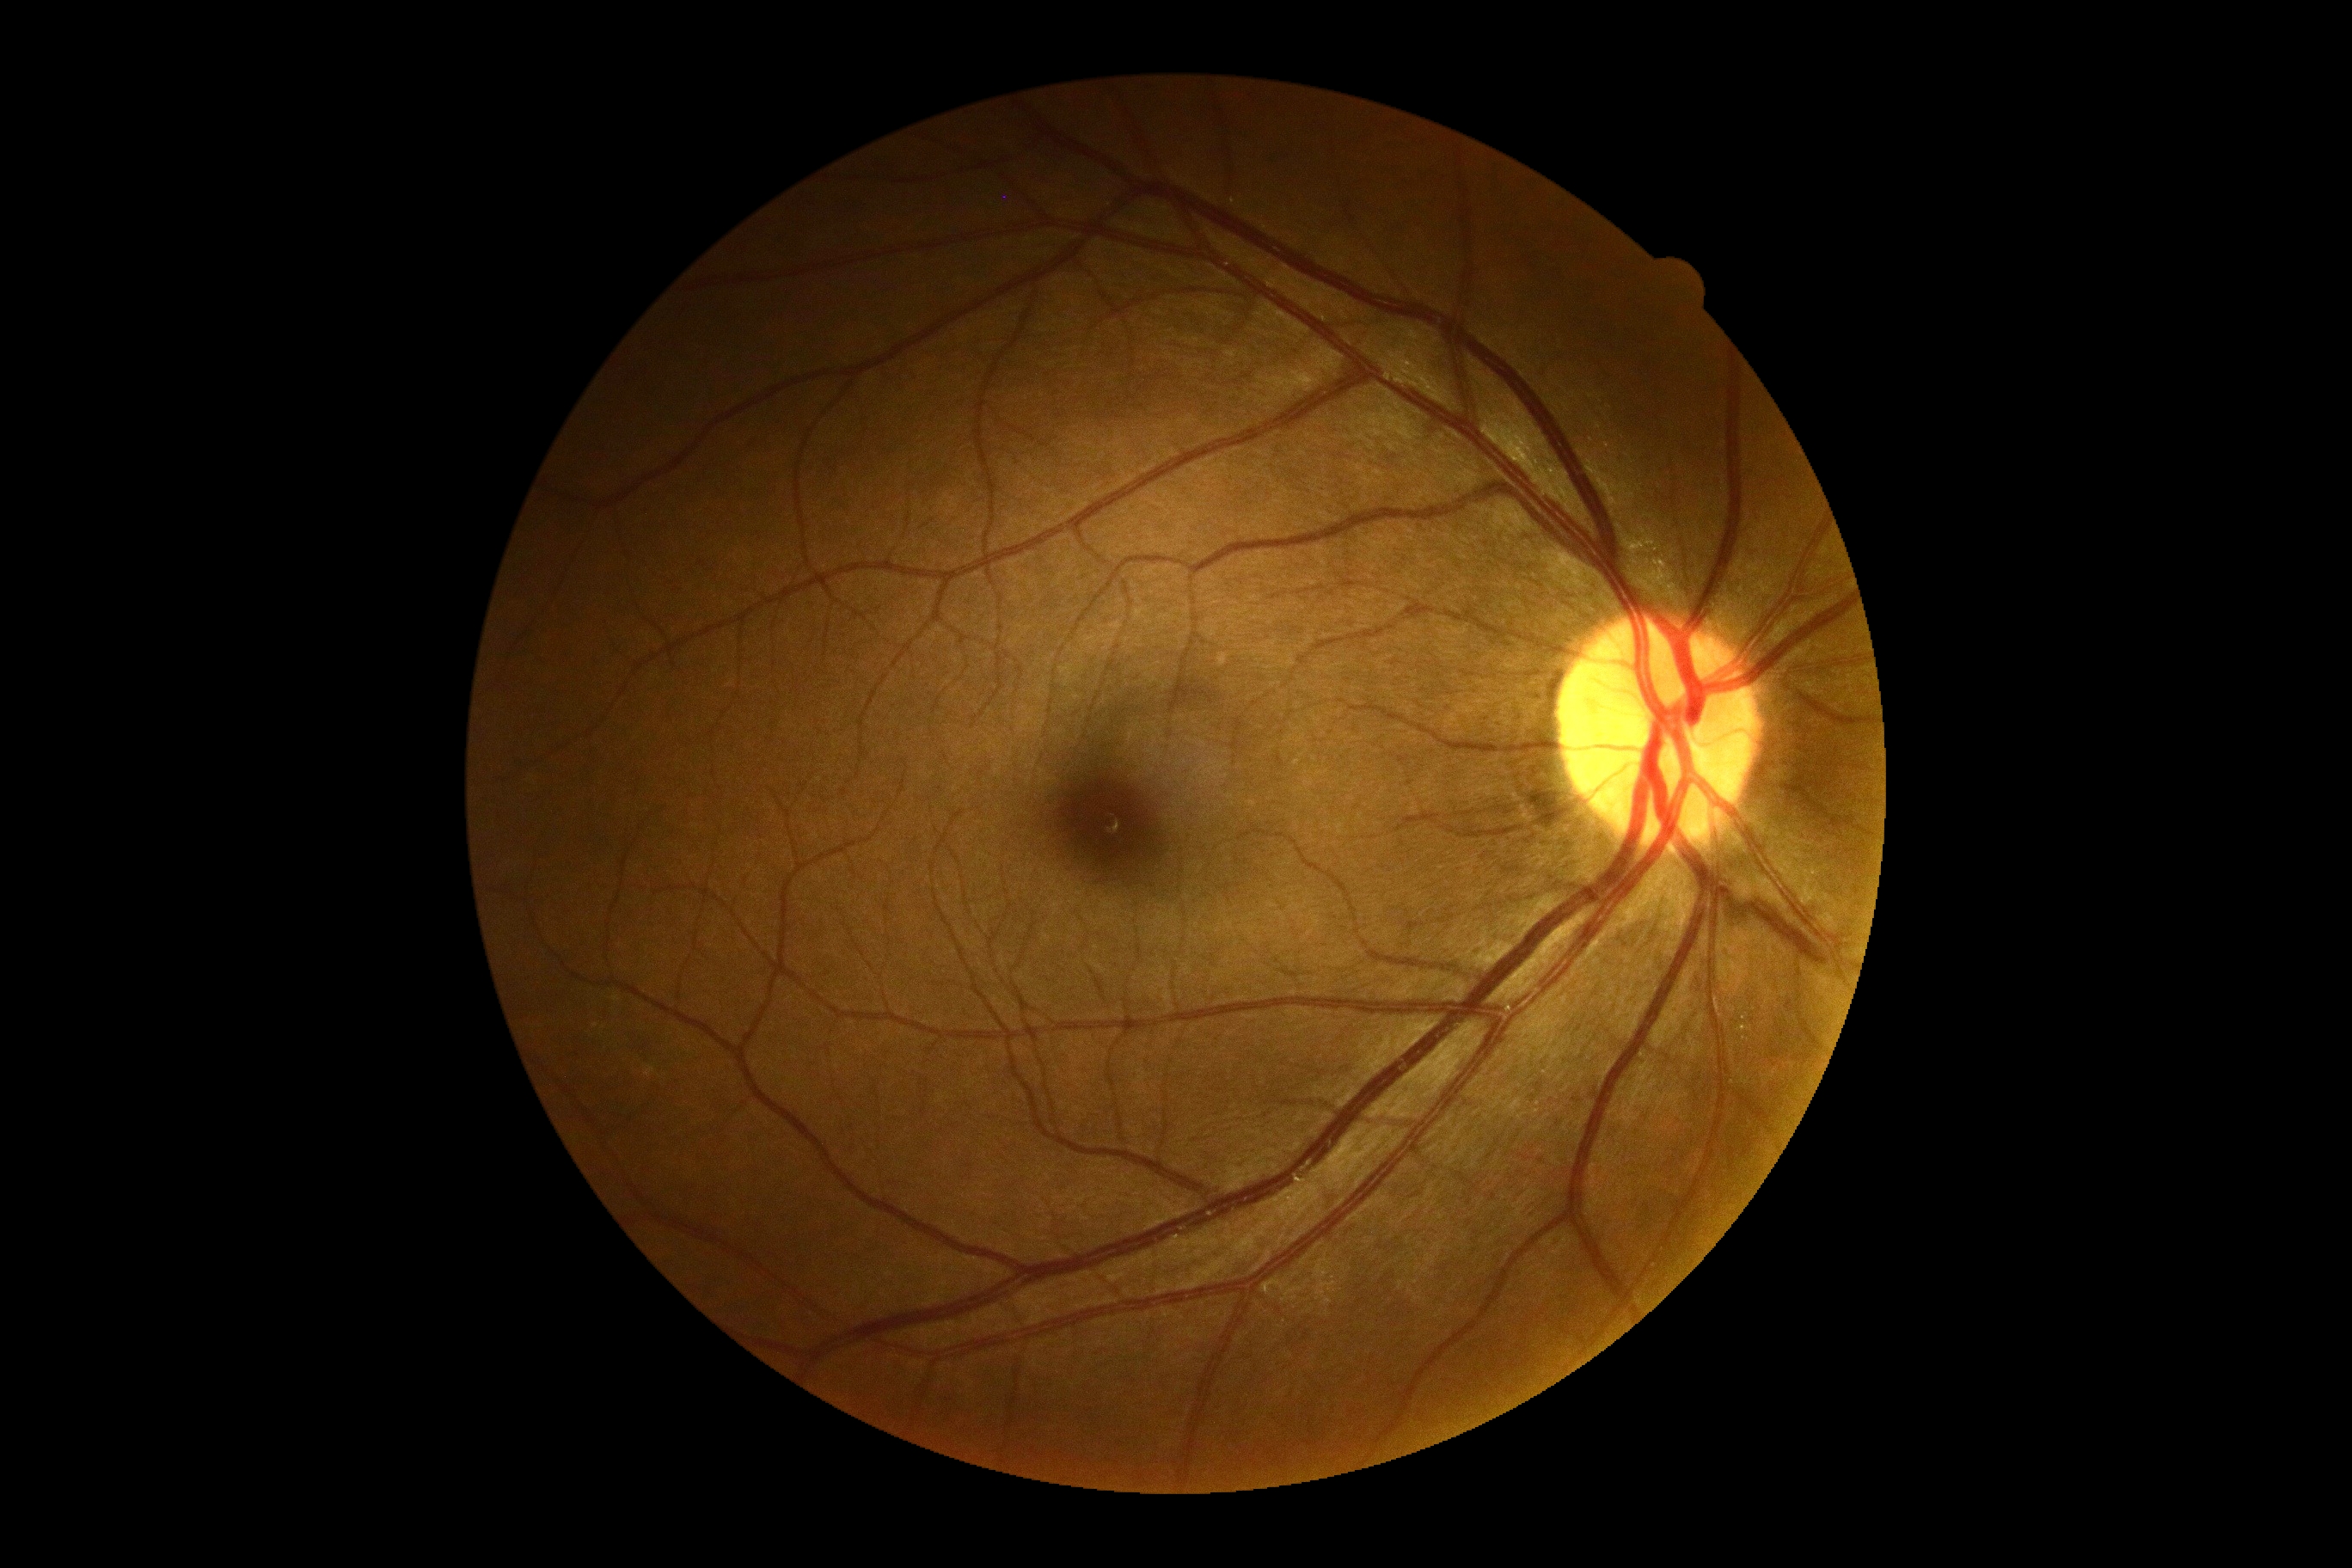
DR stage: grade 0. No diabetic retinal disease findings.